Davis DR grading; FOV: 45 degrees — 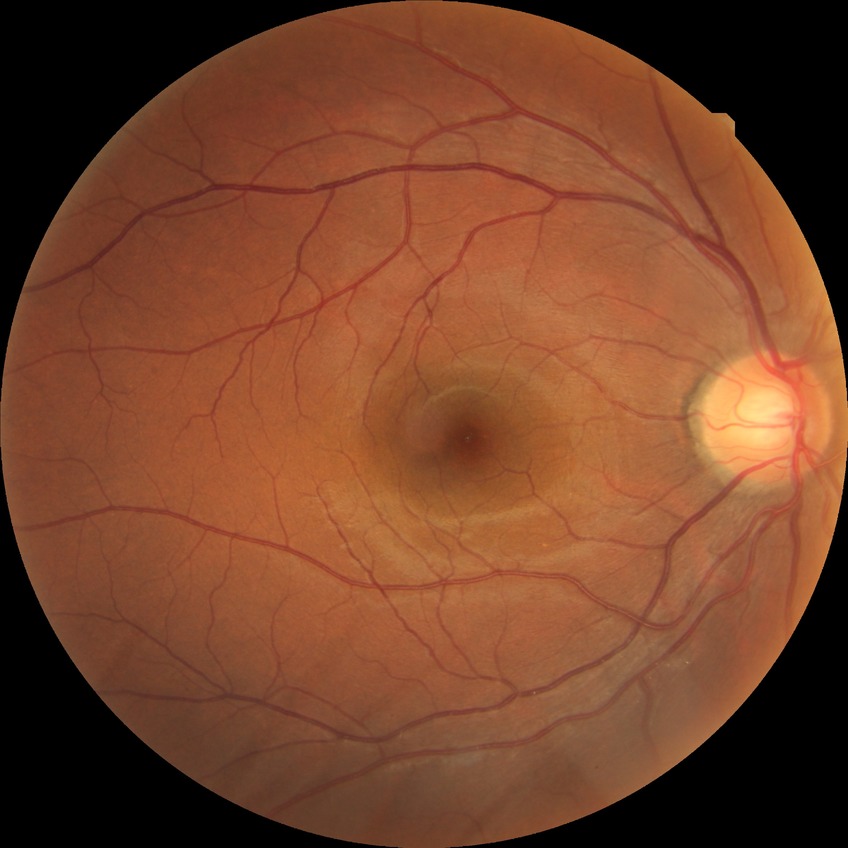
  davis_grade: NDR (no diabetic retinopathy)